2352 x 1568 pixels: 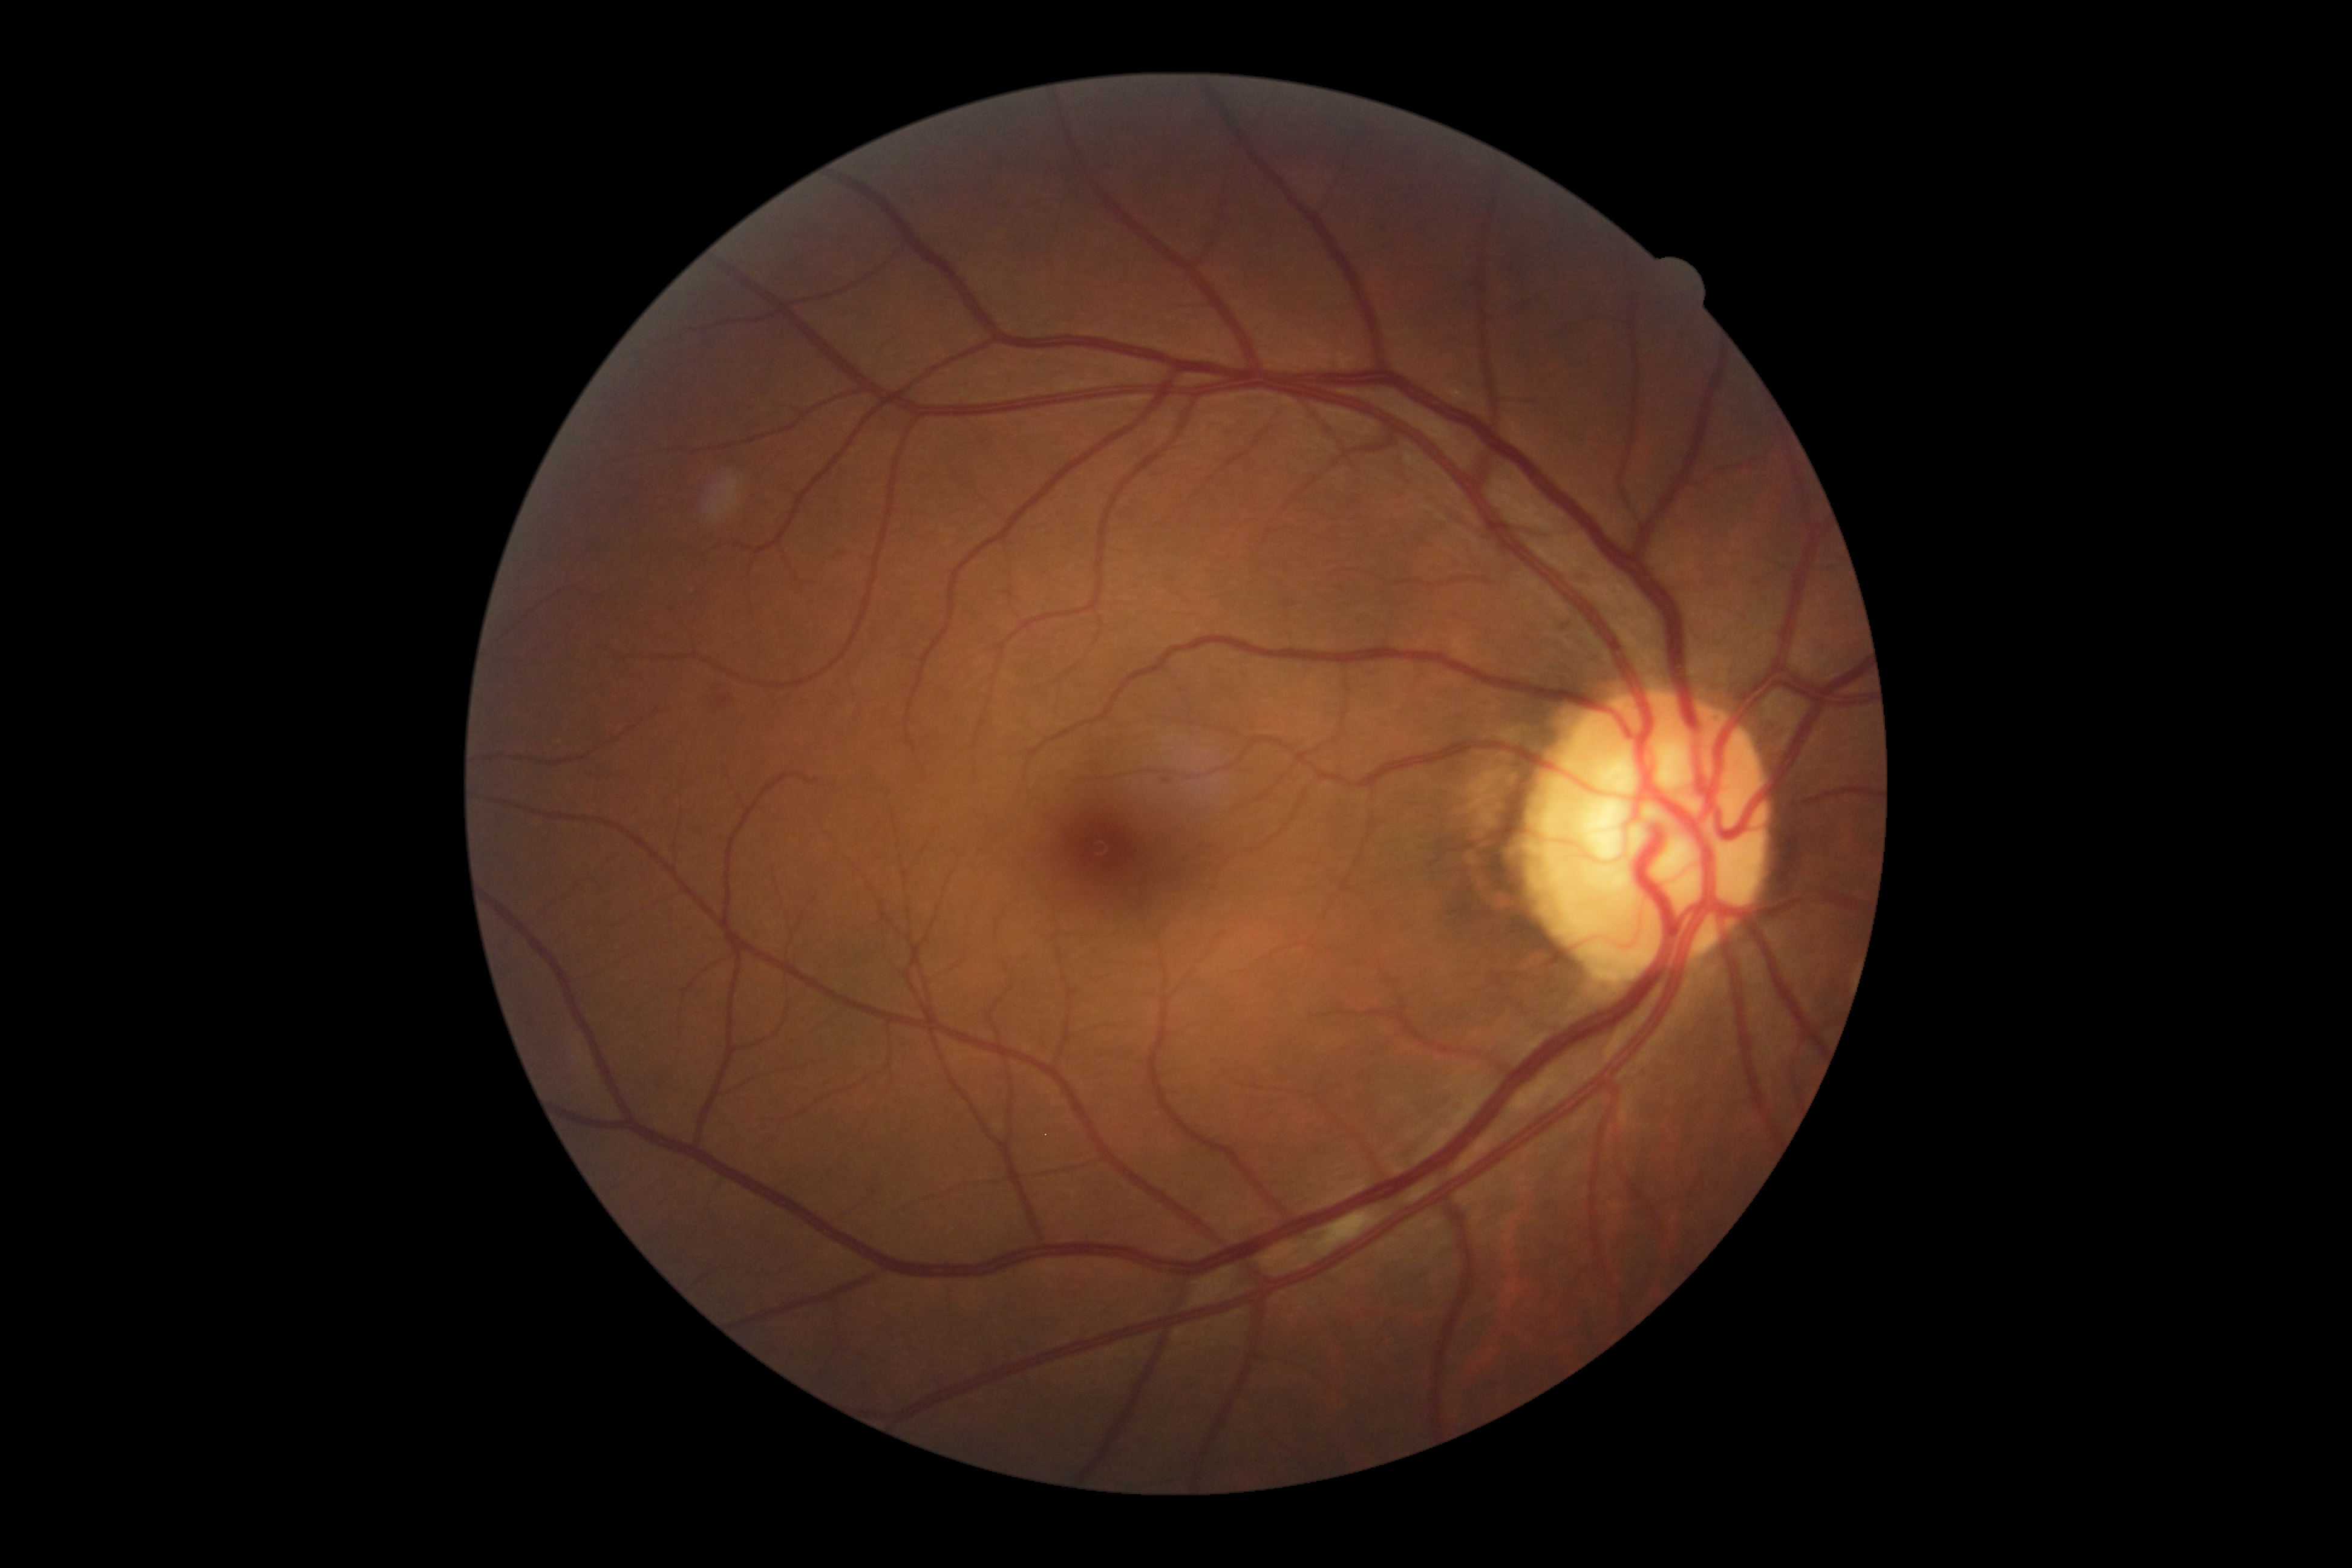

diabetic retinopathy (DR): moderate non-proliferative diabetic retinopathy (grade 2) — more than just microaneurysms but less than severe NPDR, DR class: non-proliferative diabetic retinopathy.